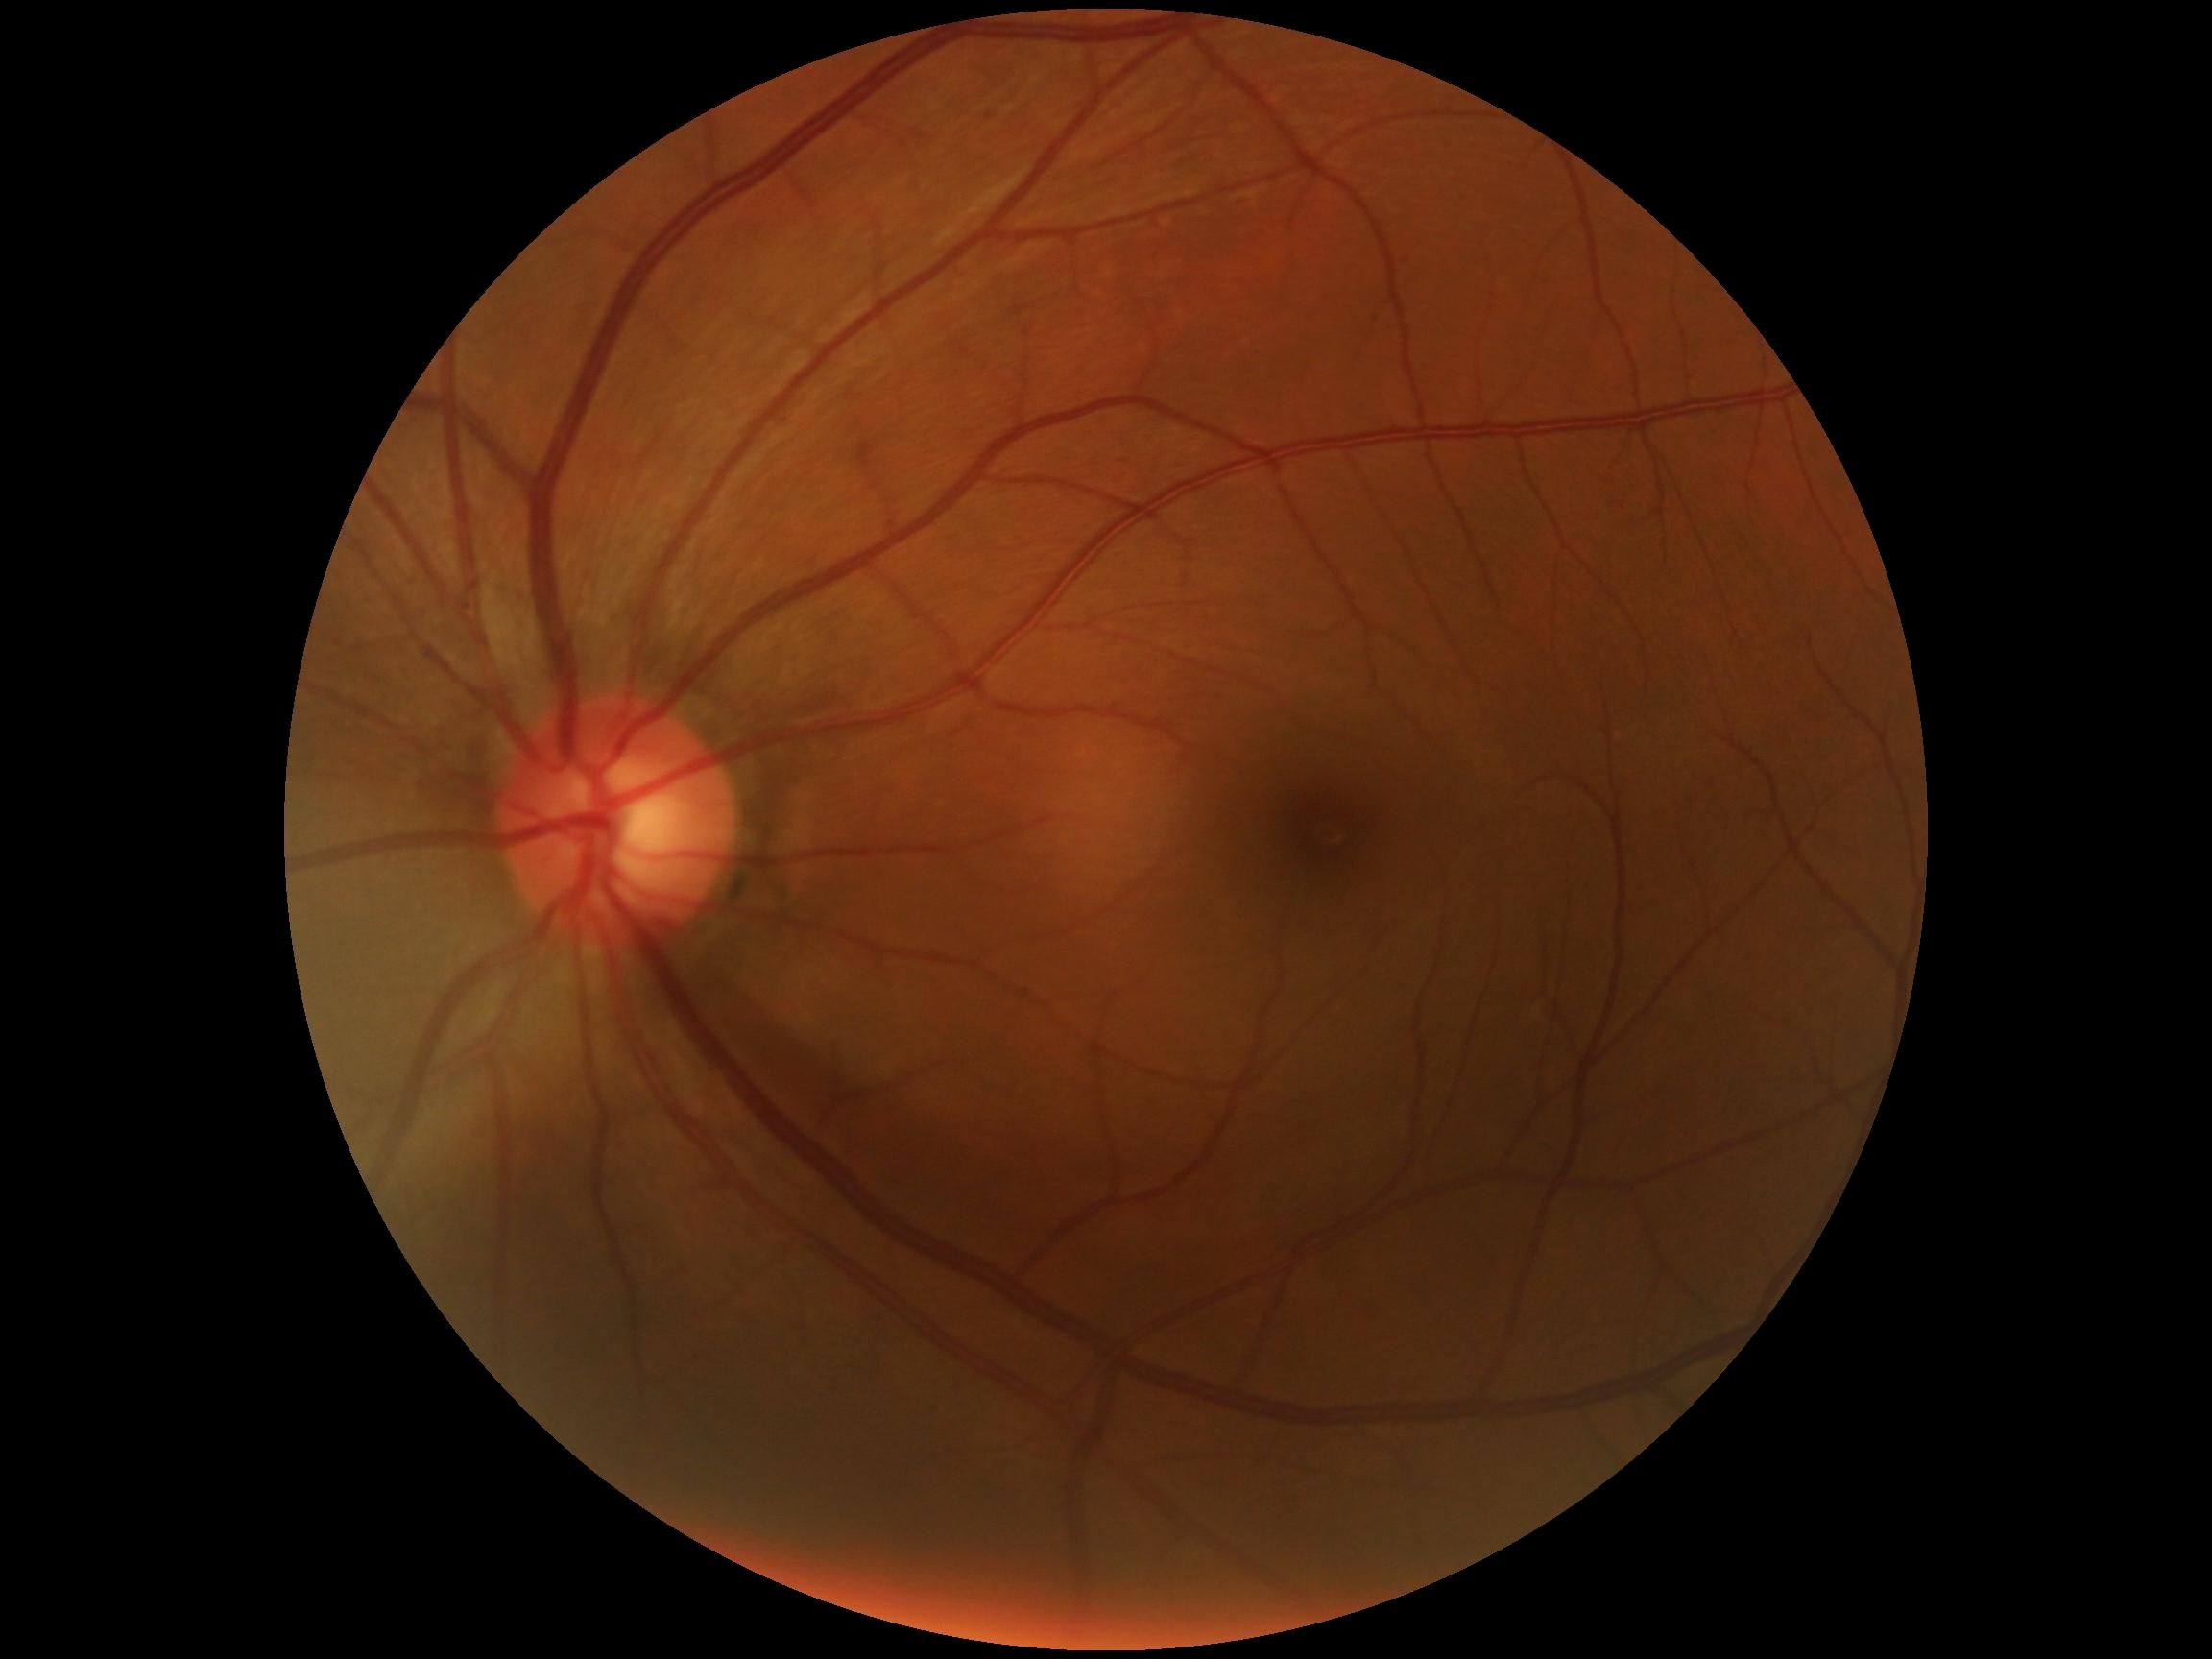
Findings:
- DR impression: no DR findings
- DR severity: no apparent retinopathy (grade 0)